848 x 848 pixels · nonmydriatic · posterior pole photograph · NIDEK AFC-230 · FOV: 45 degrees
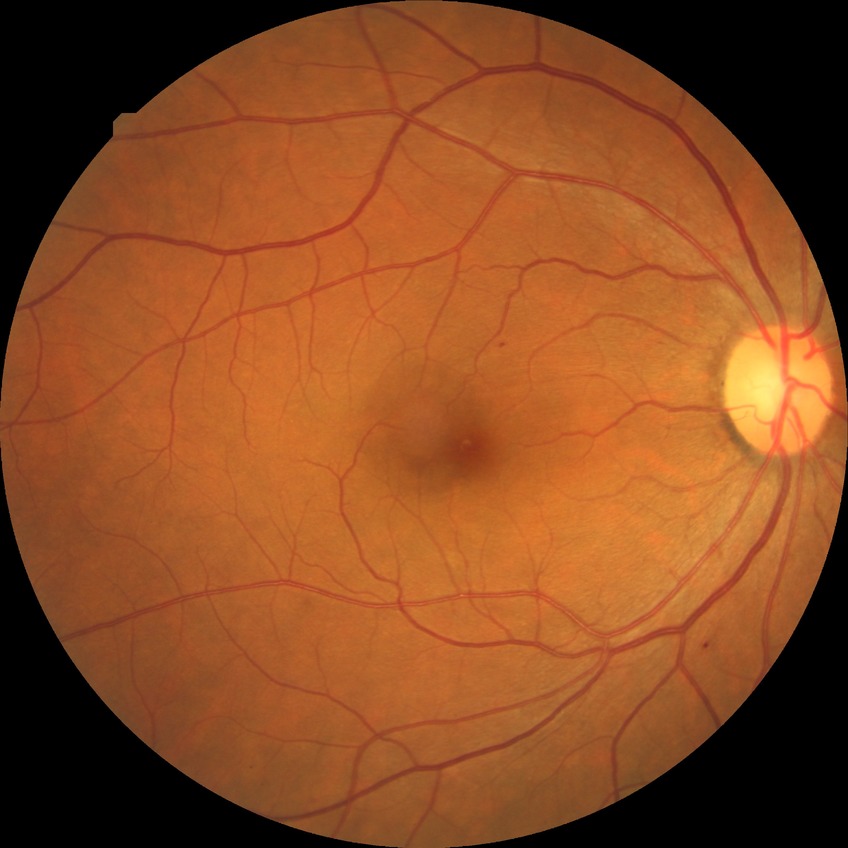
DR class@non-proliferative diabetic retinopathy; Davis grading@simple diabetic retinopathy.